Image size 1932x1910; 45° FOV.
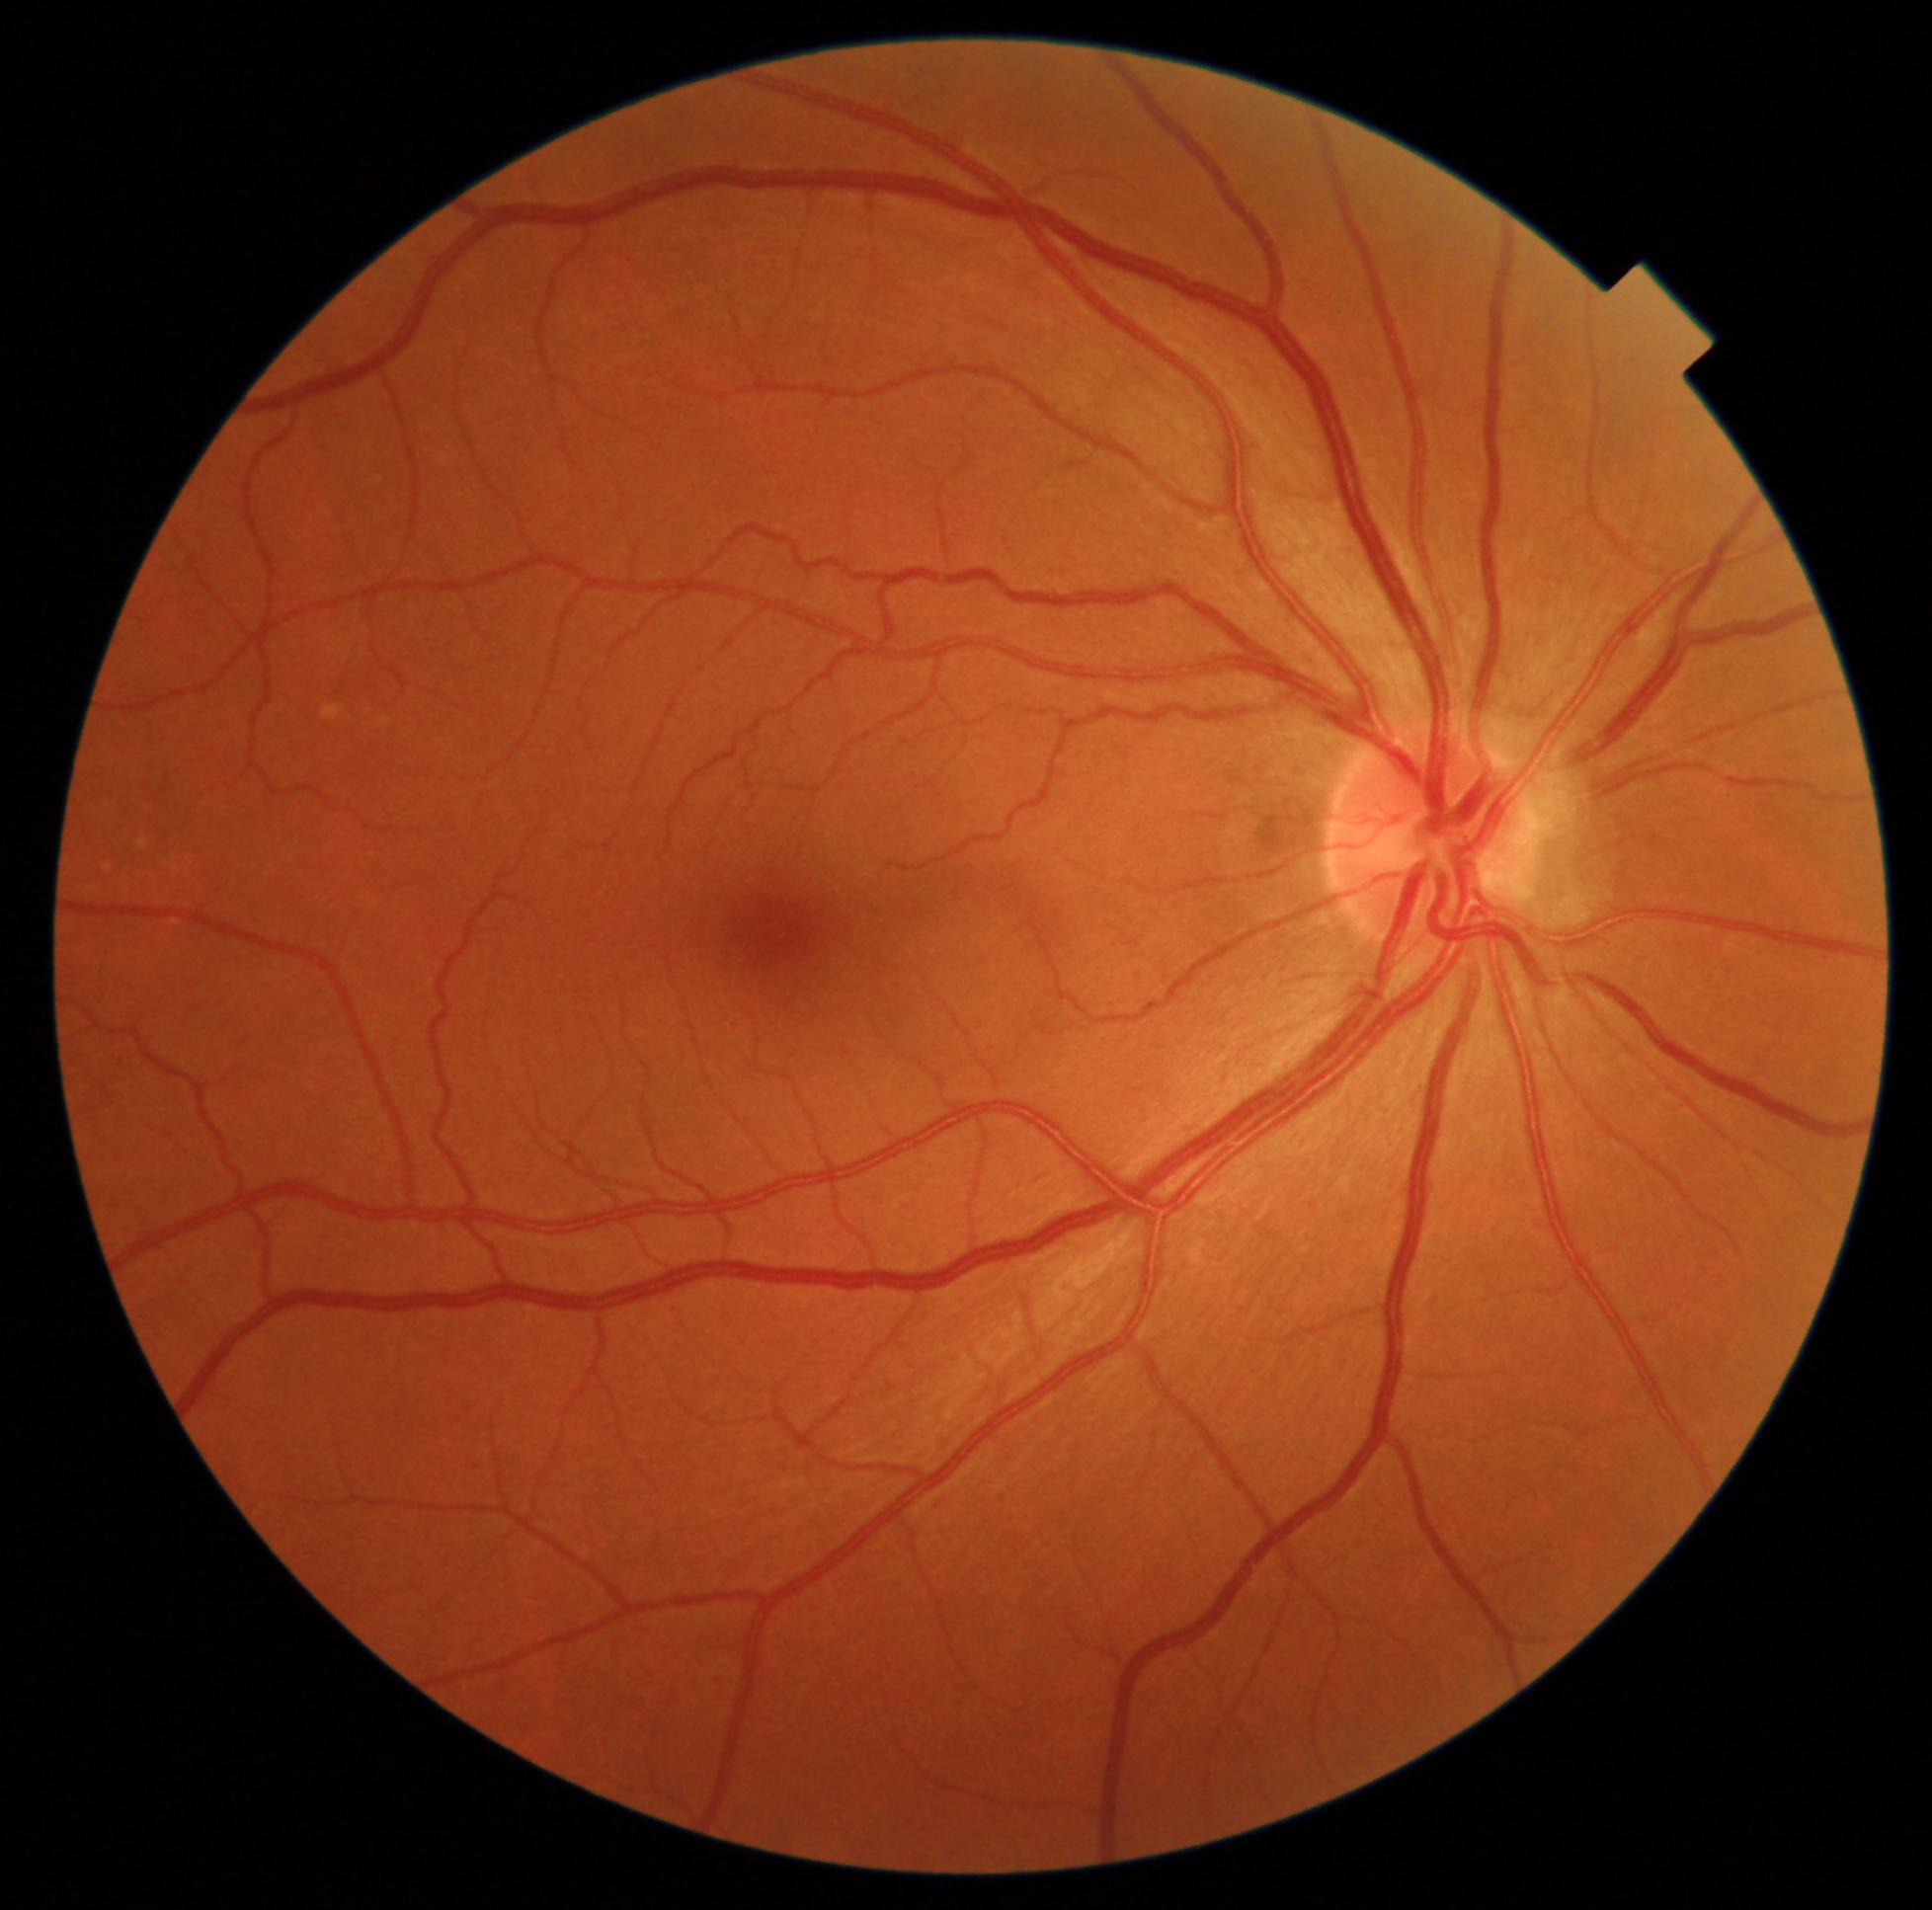
retinopathy = grade 0.